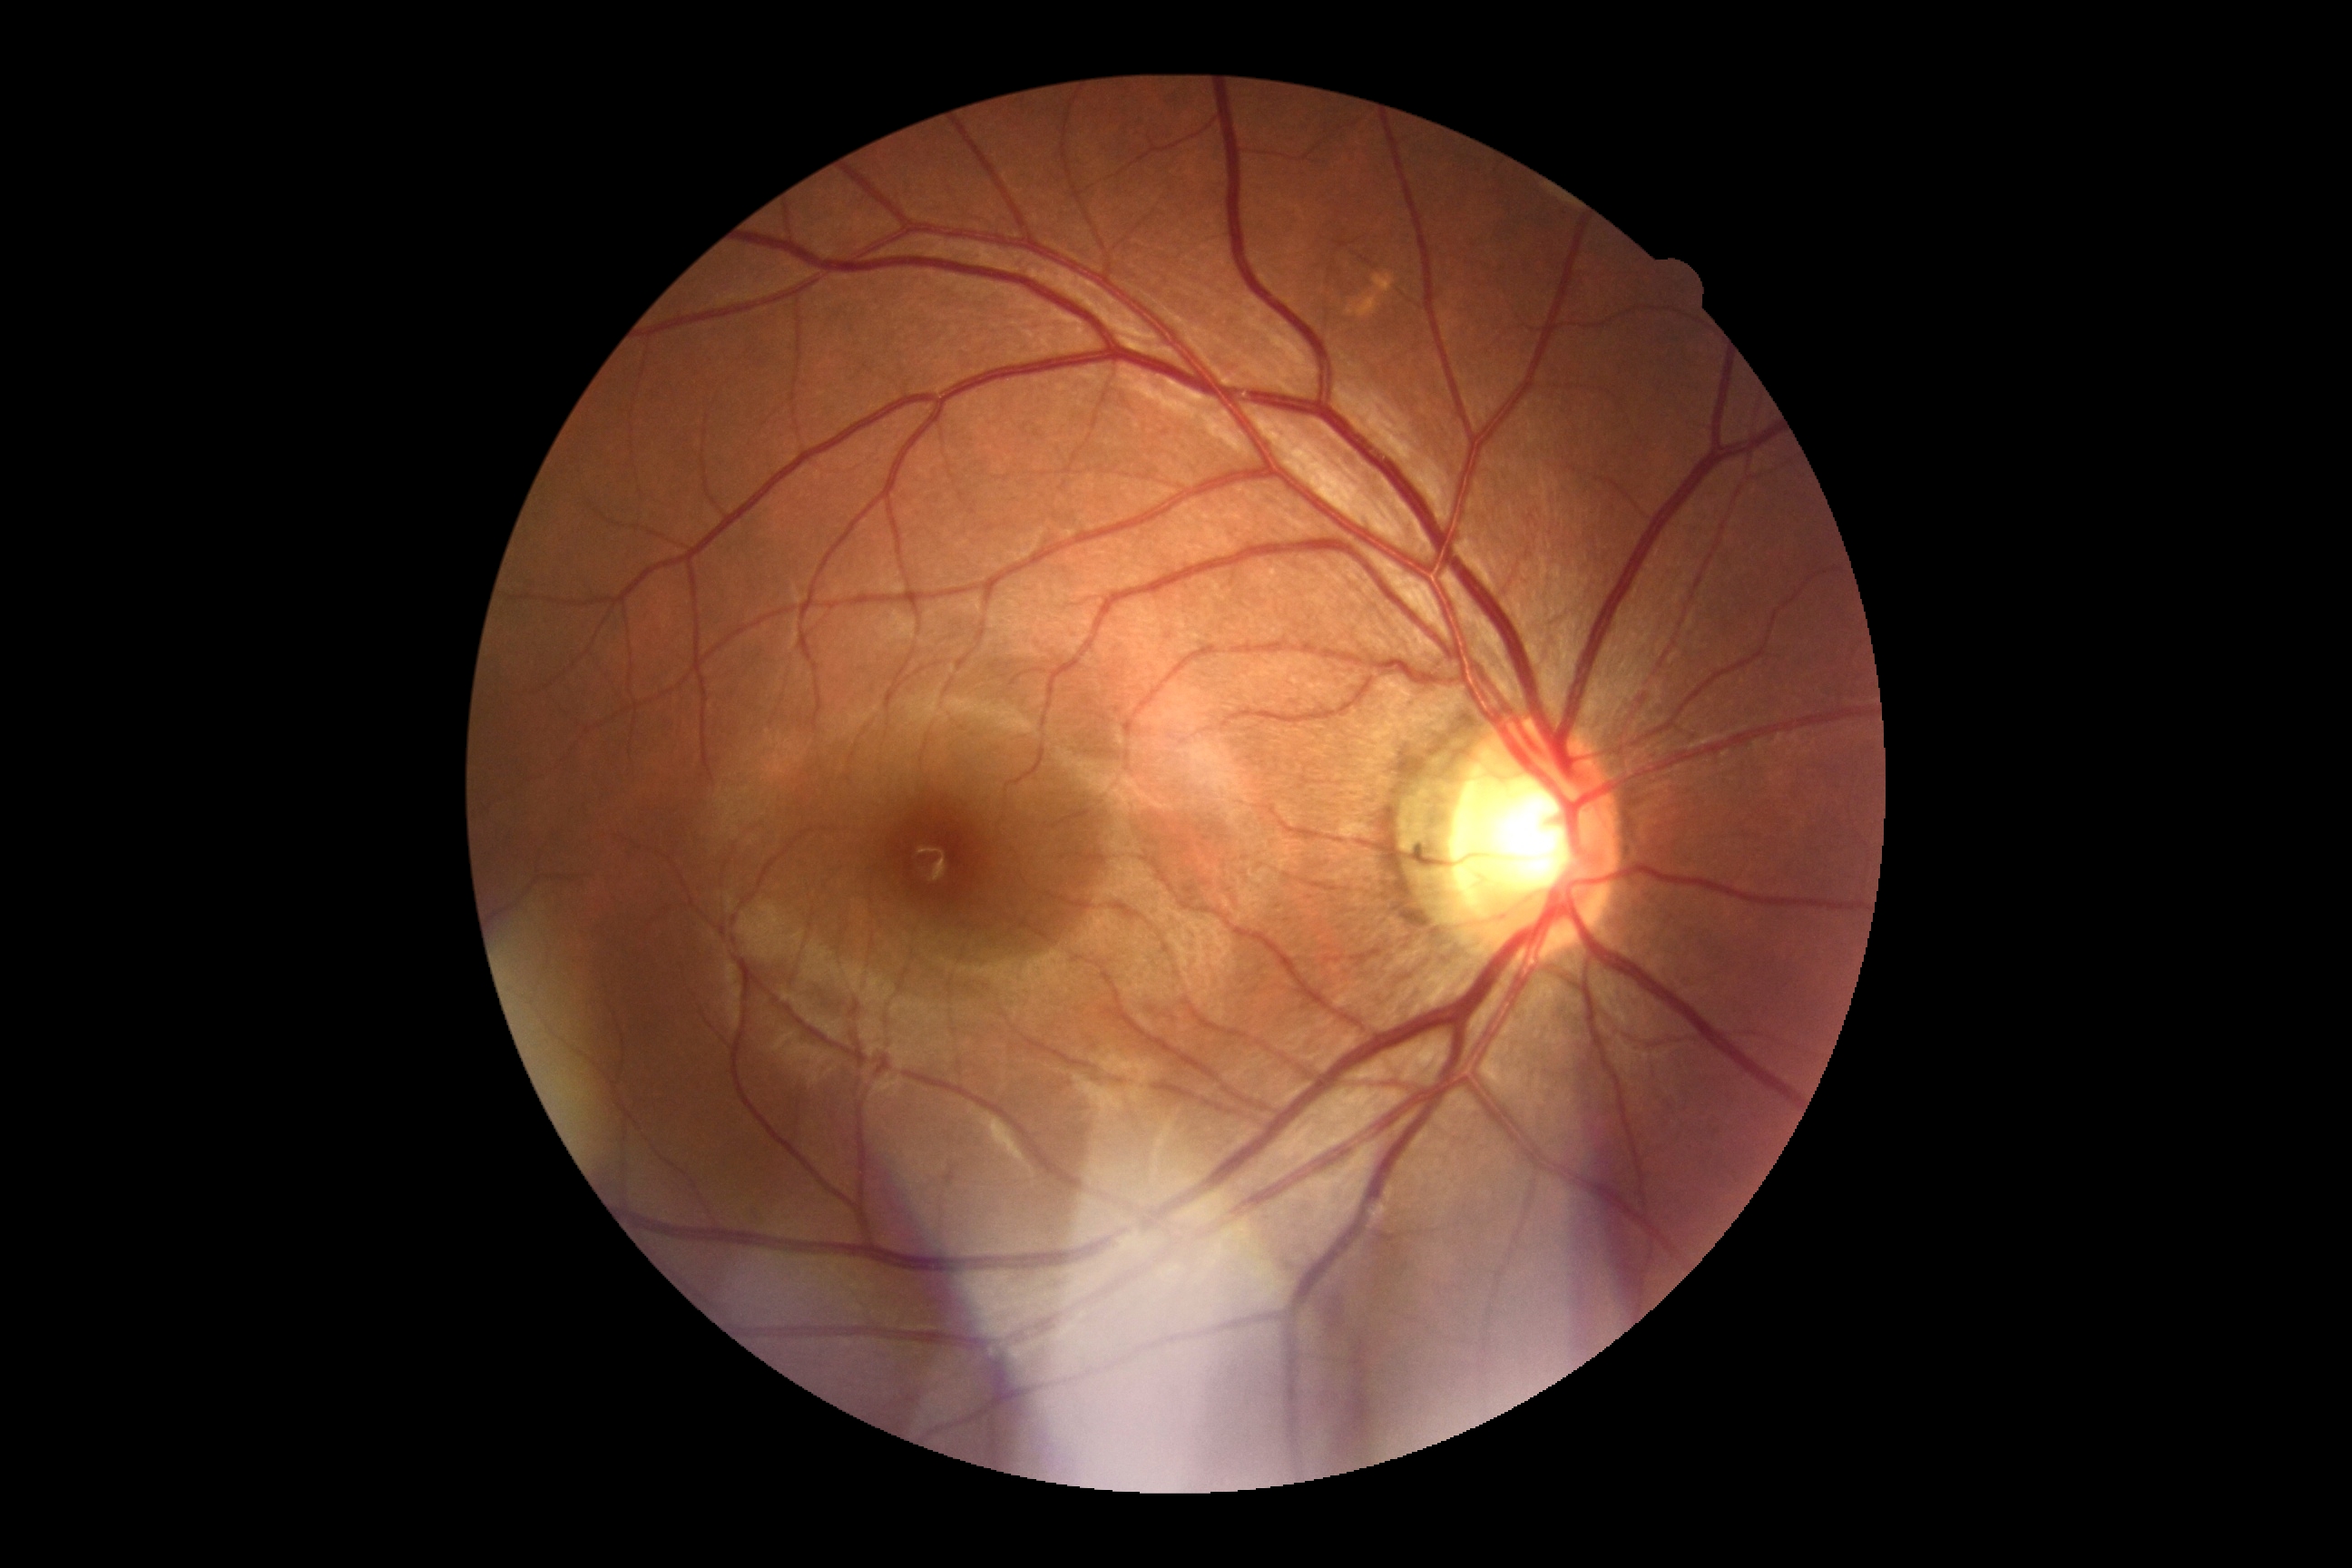
diabetic retinopathy (DR)@0.